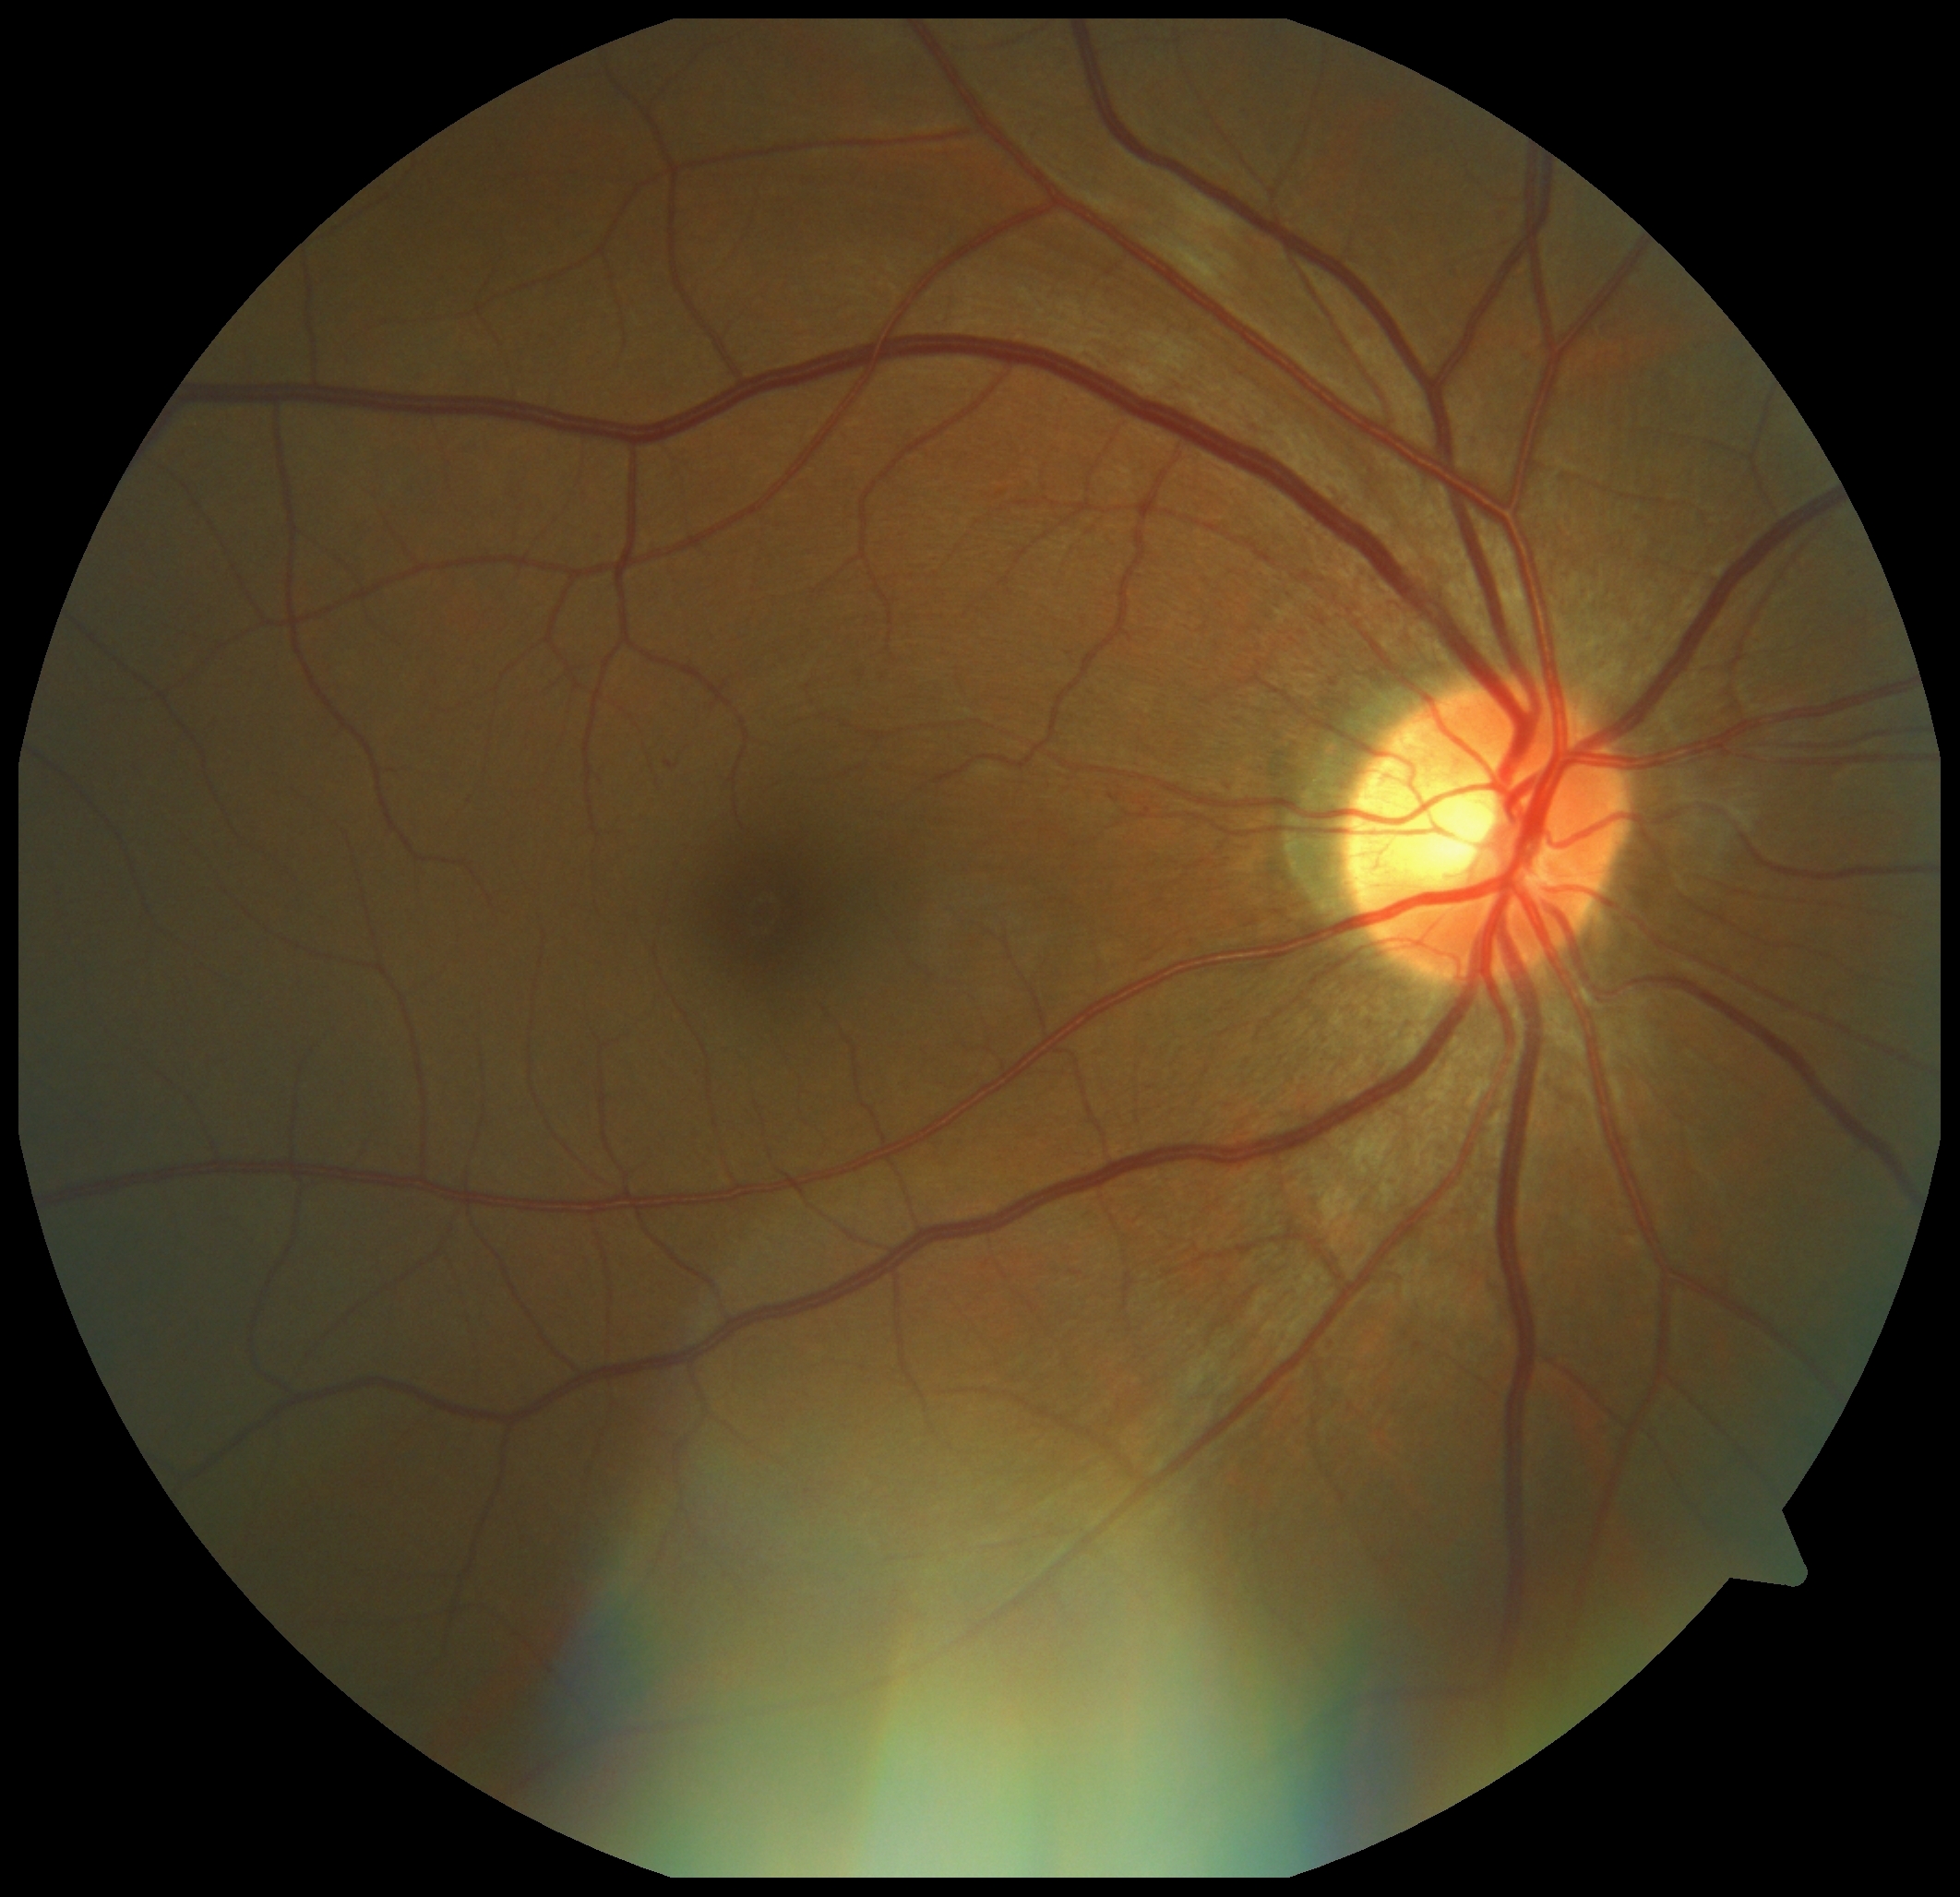 Disease class: non-proliferative diabetic retinopathy.
DR is grade 1 (mild NPDR) — presence of microaneurysms only.